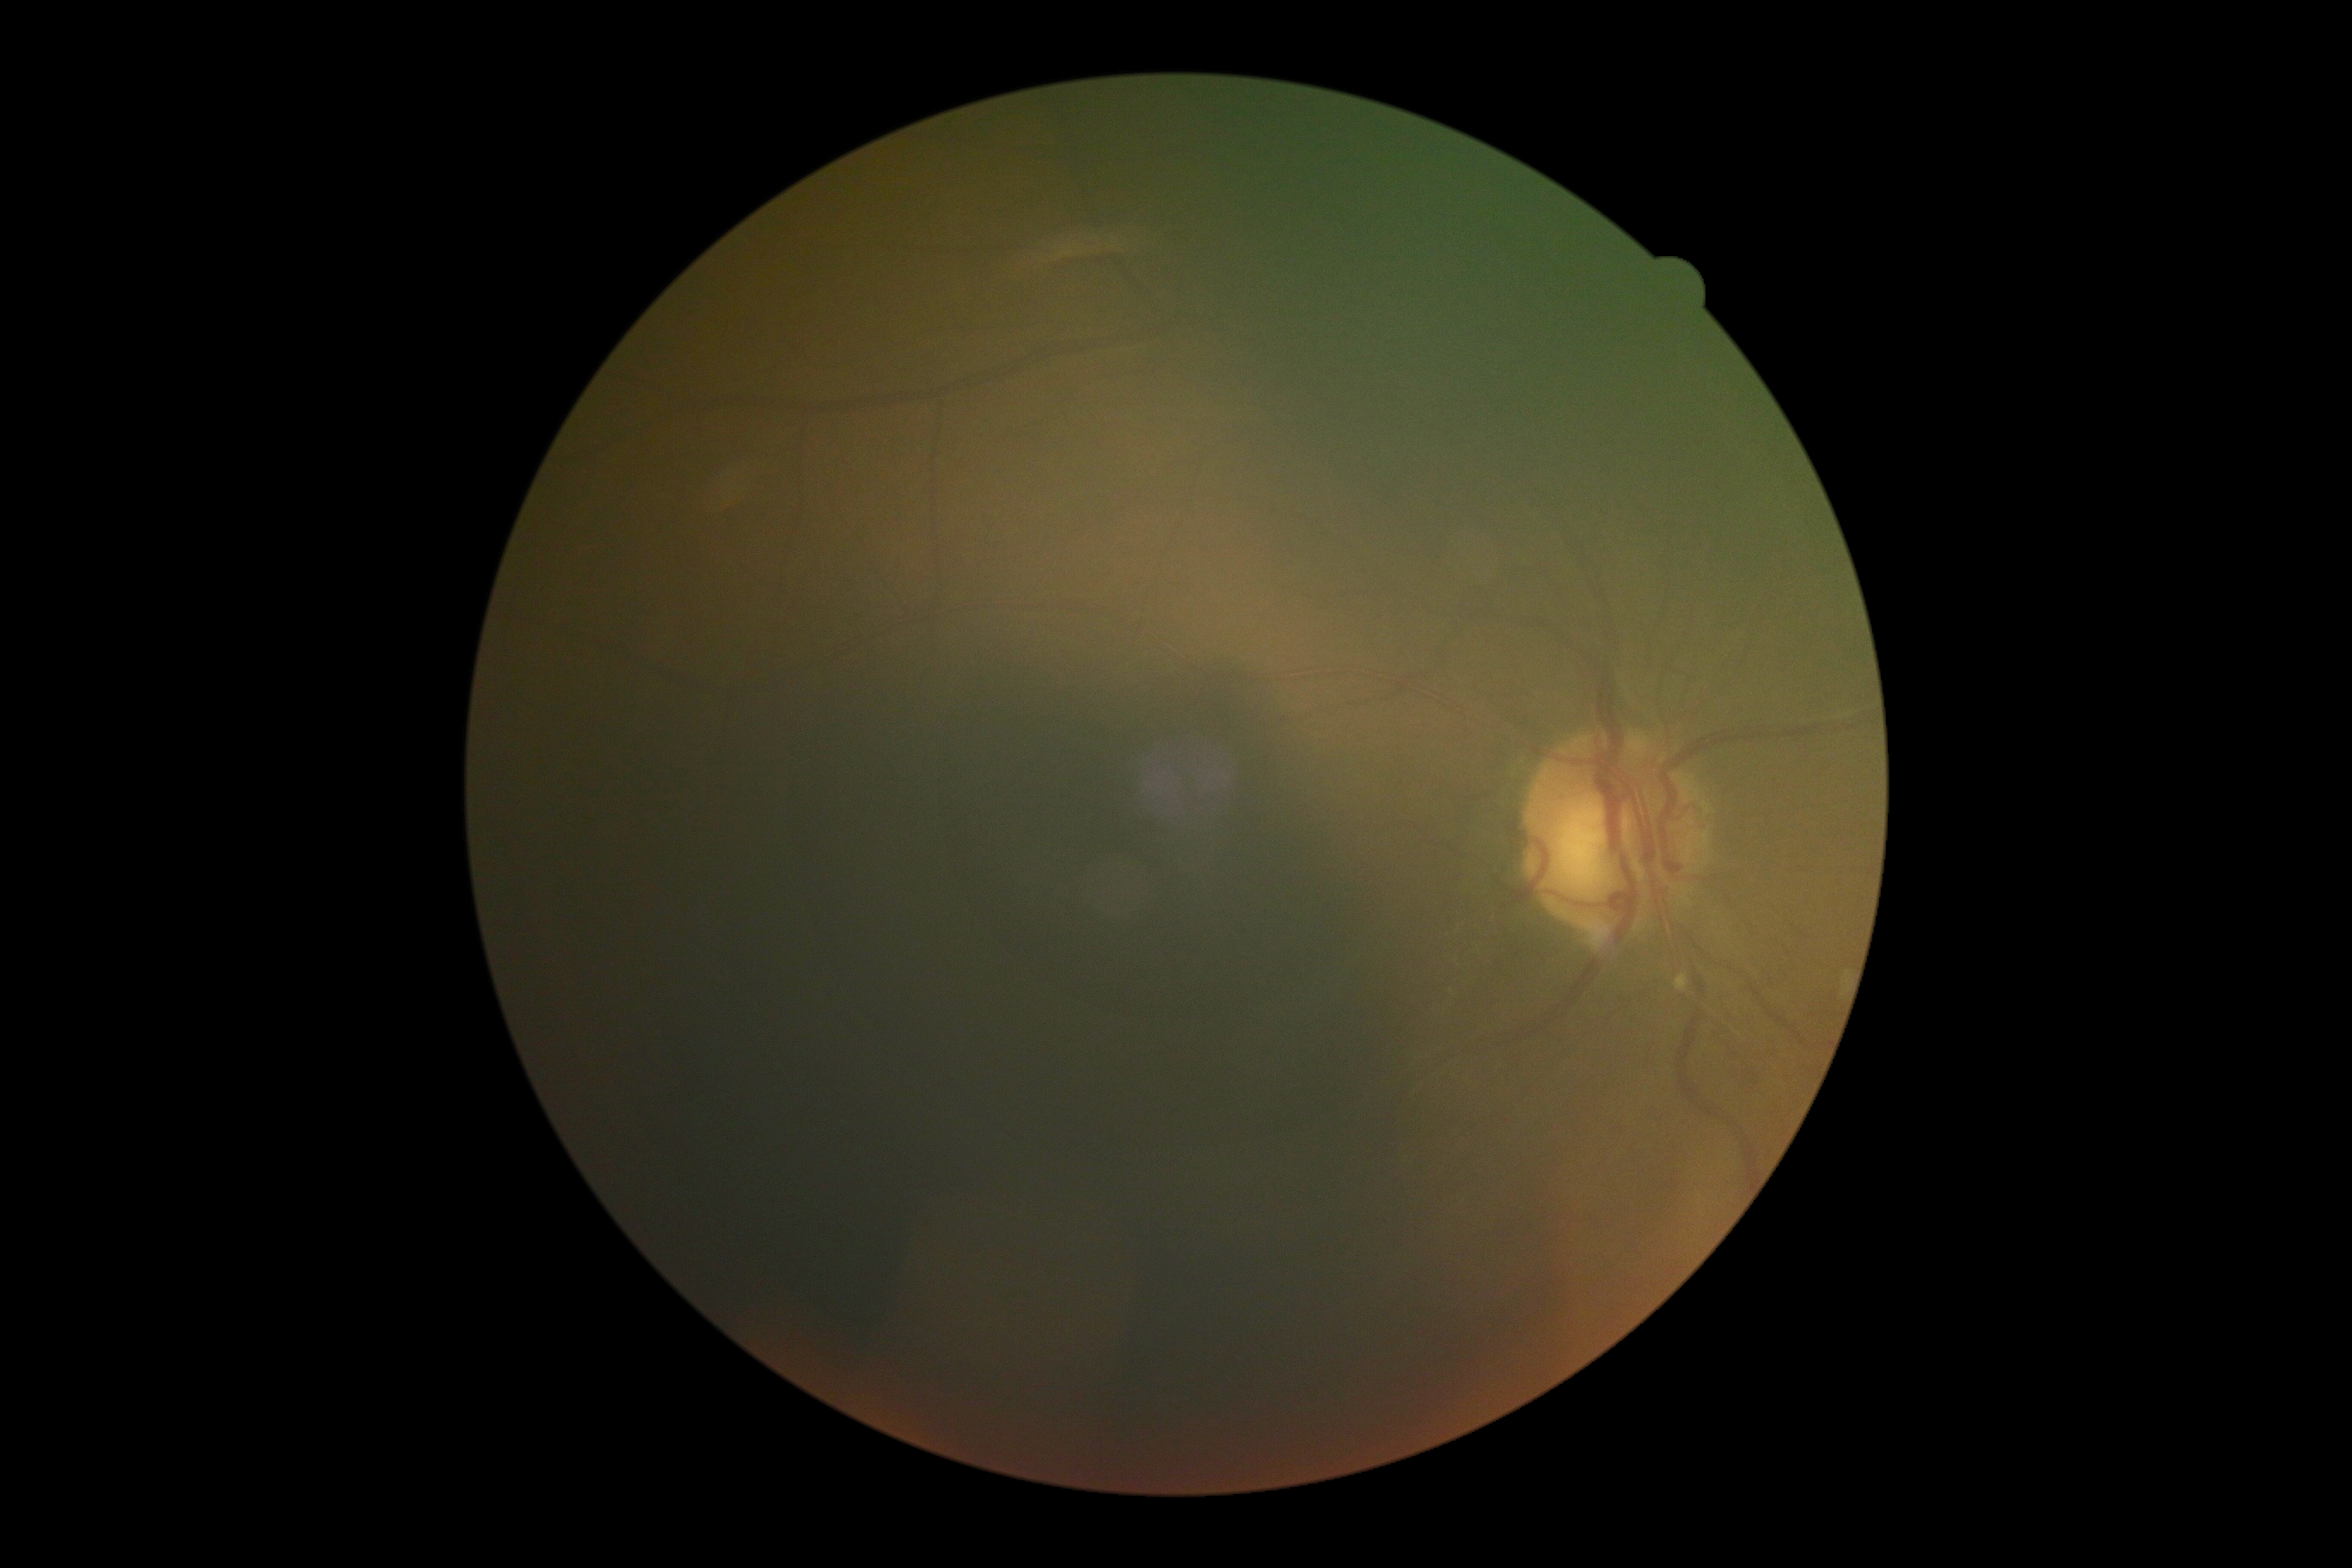 DR stage: ungradable.